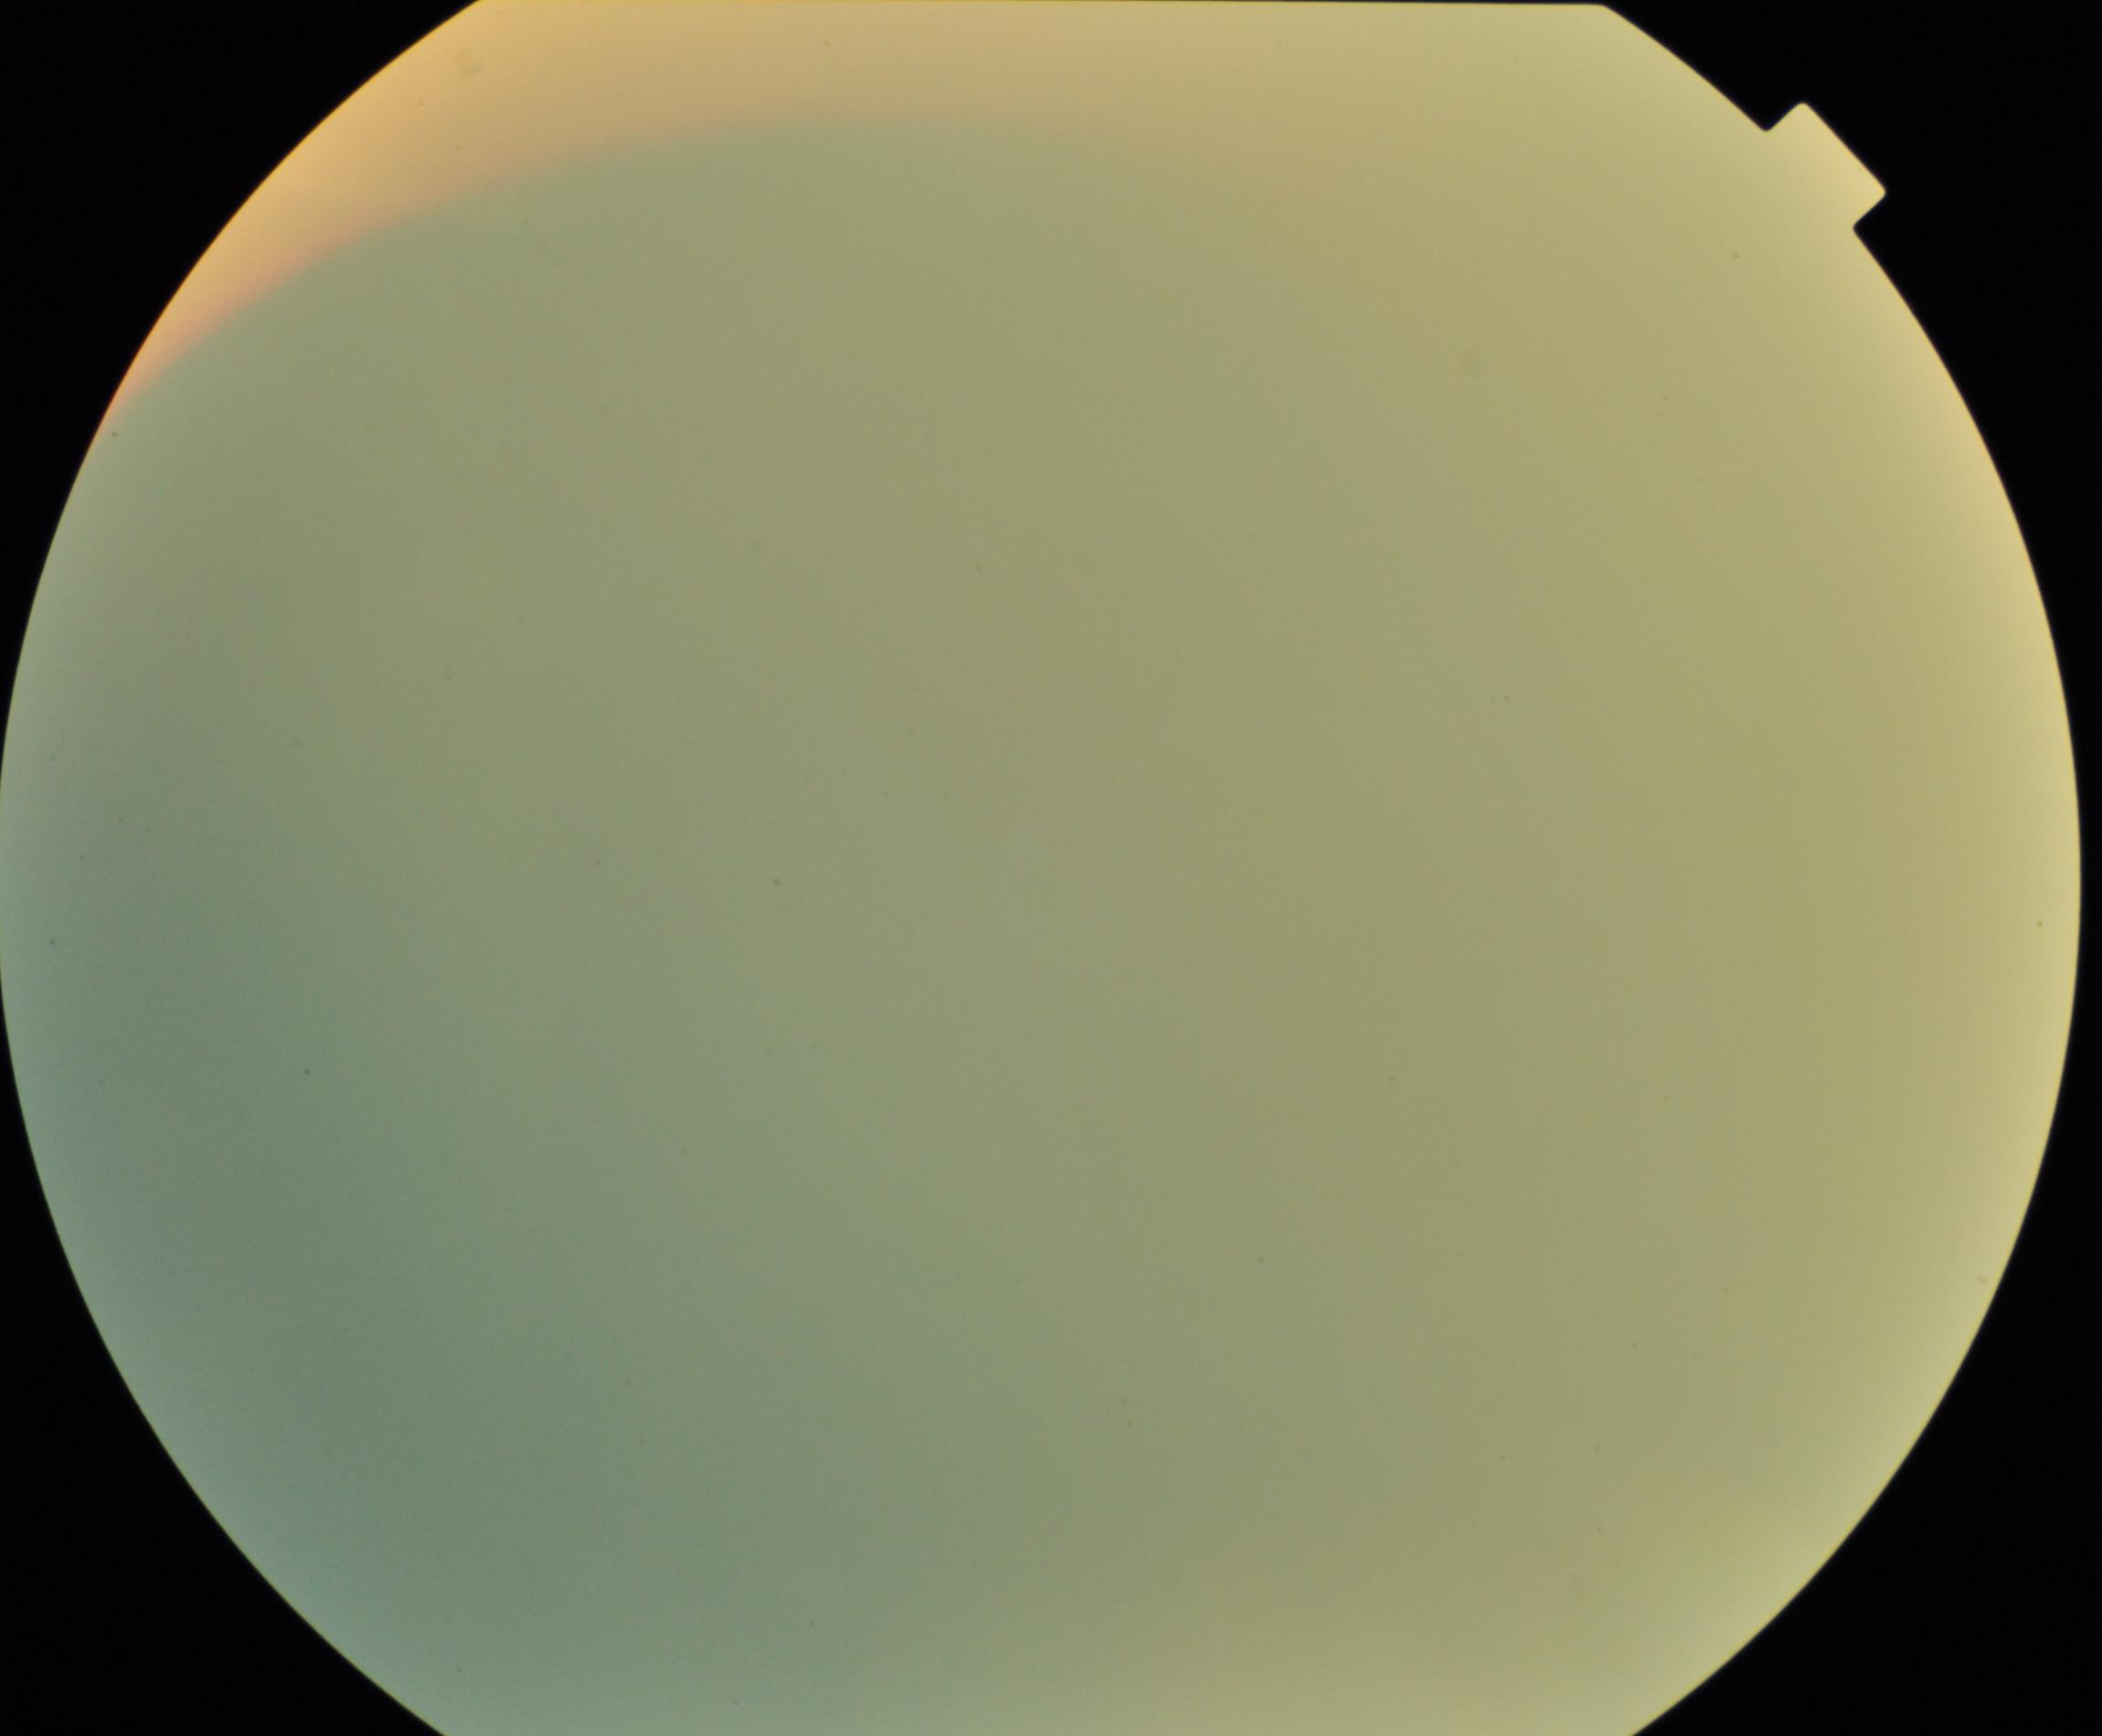

Gradability: poor. Proliferative retinopathy: negative.